Infant wide-field retinal image — 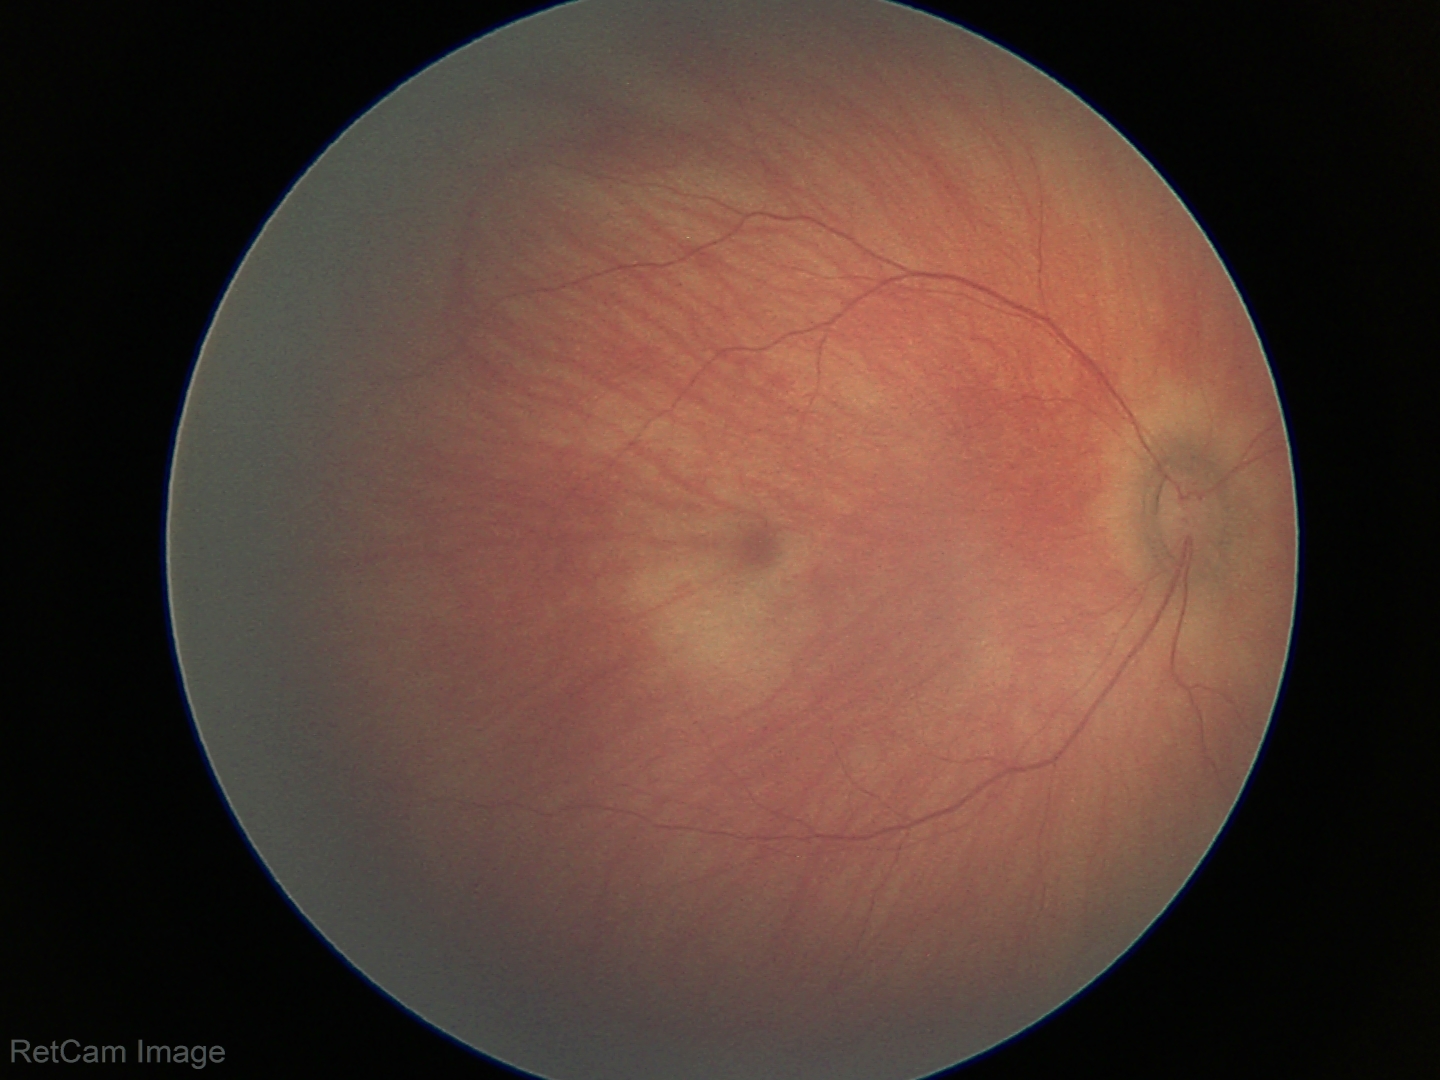 Physiological retinal appearance for postconceptual age.